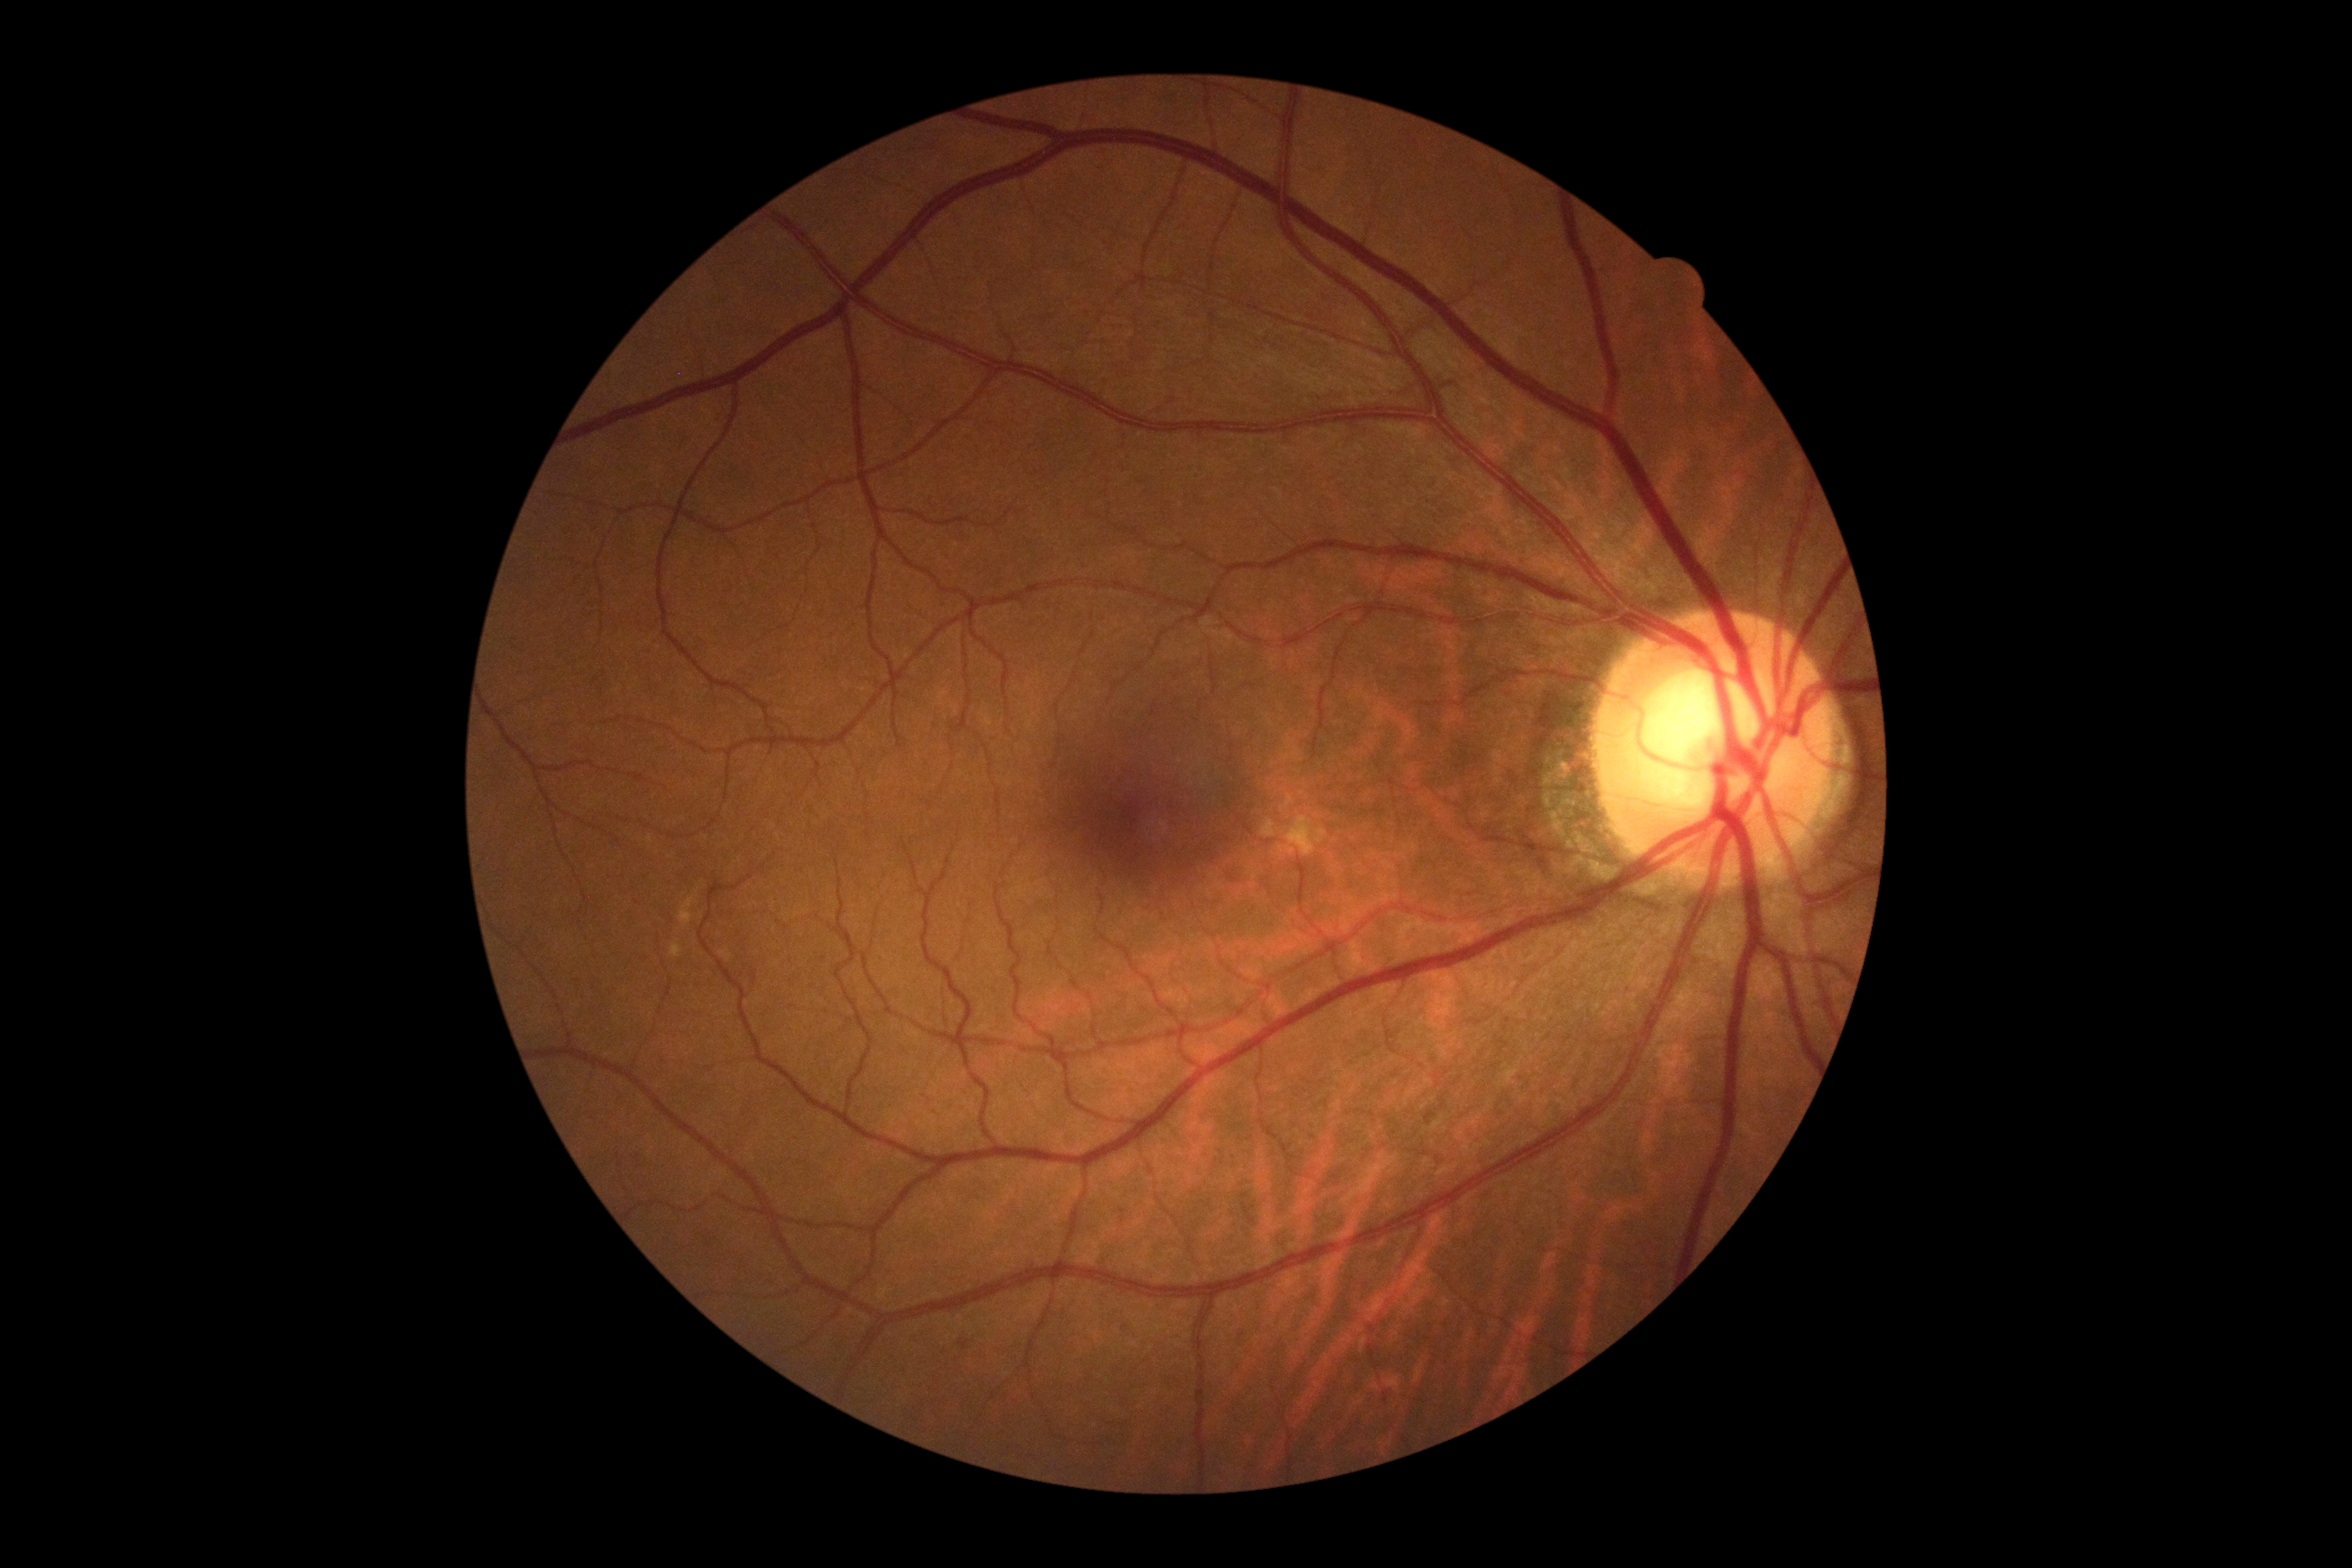
Diabetic retinopathy (DR): grade 0 (no apparent retinopathy) — no visible signs of diabetic retinopathy.
No signs of diabetic retinopathy.